2361x1568
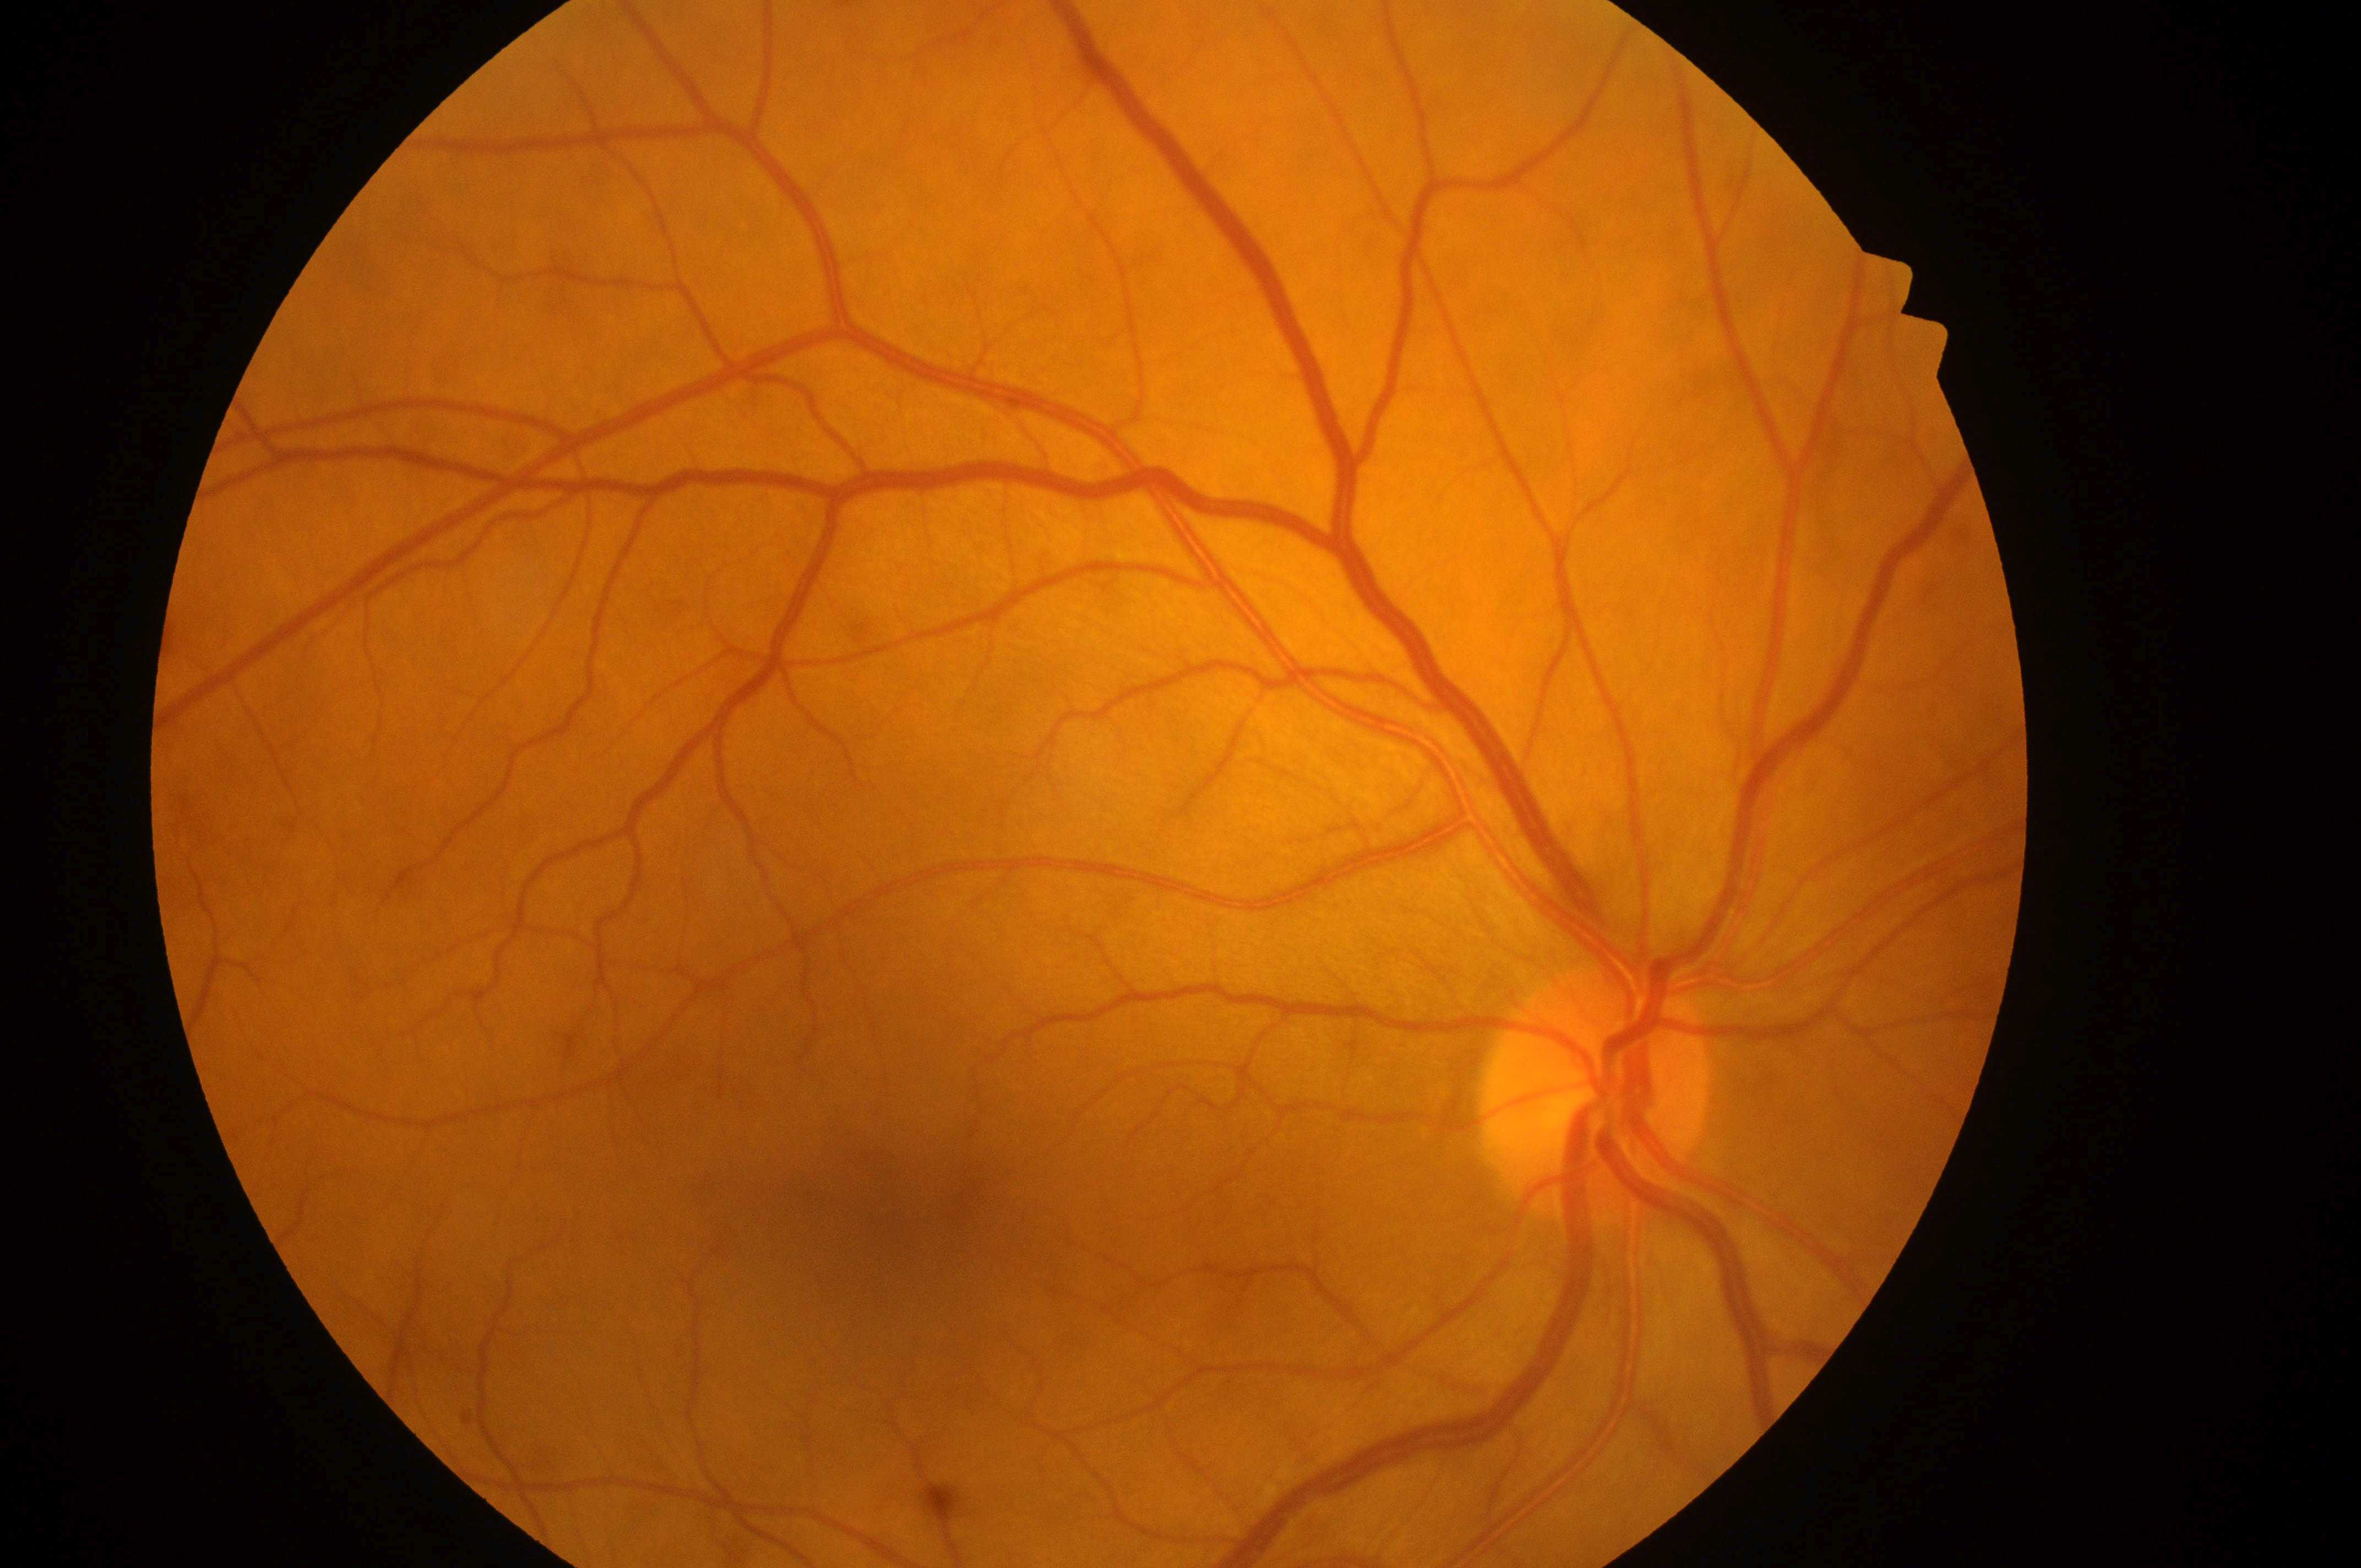 Annotations:
– DR — no apparent diabetic retinopathy (grade 0)
– DR impression — No DR or DME findings
– DME grade — no risk (0)
– laterality — the right eye
– fovea center — 897px, 1235px
– optic disc — 1592px, 1107px